Optic disc-centered crop
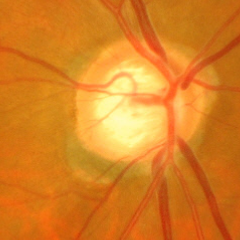 Showing early glaucomatous changes.